Diabetic retinopathy graded by the modified Davis classification:
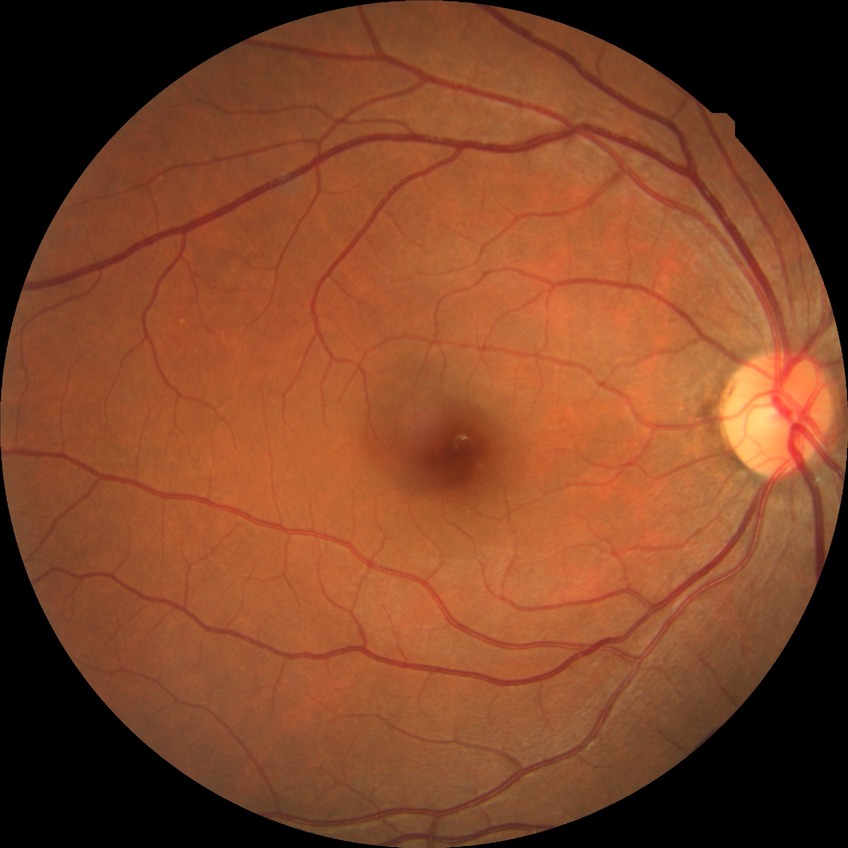
Diabetic retinopathy severity: no diabetic retinopathy.